Fundus photo, diabetic retinopathy graded by the modified Davis classification:
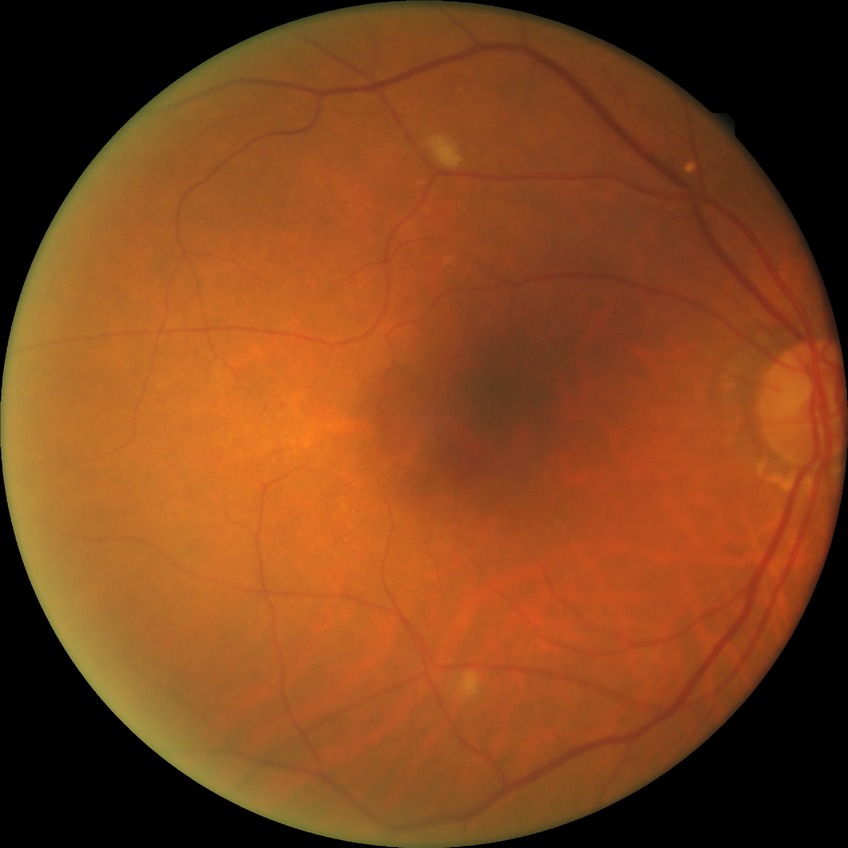 Davis grading: pre-proliferative diabetic retinopathy